Fundus photo, 2346x1568, 45-degree field of view:
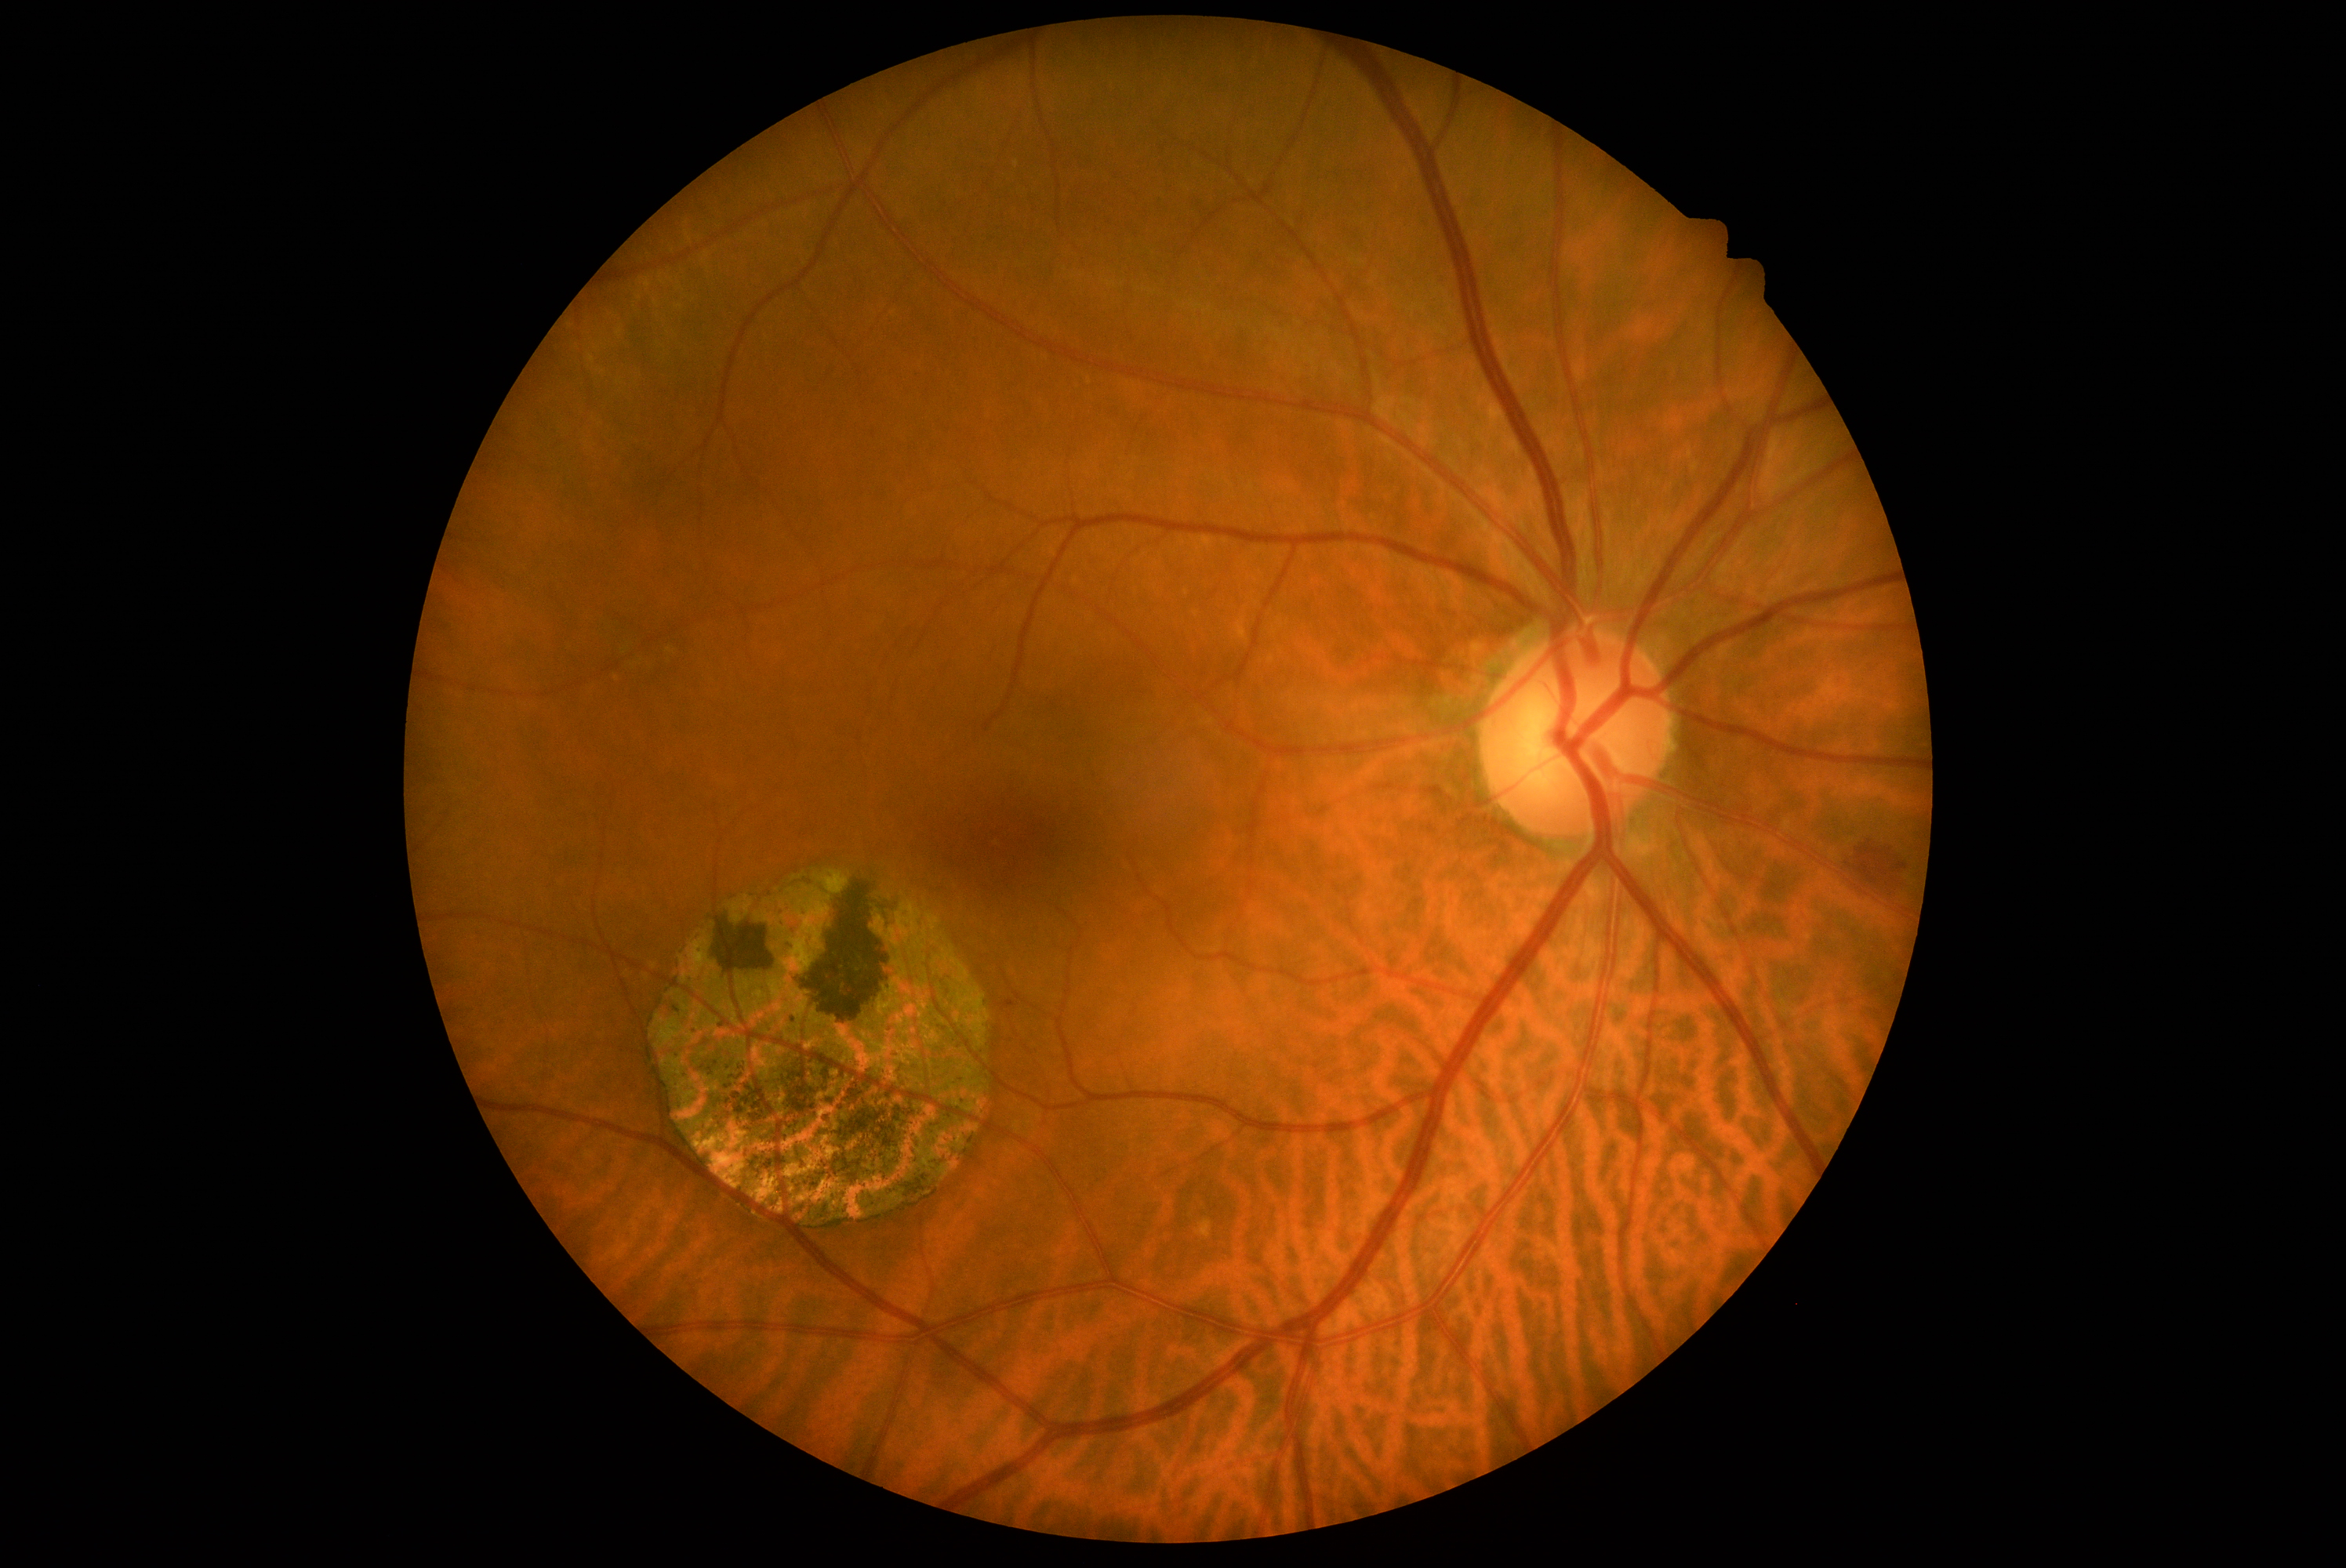
The retinopathy is classified as non-proliferative diabetic retinopathy.
DR stage: grade 2 (moderate NPDR).